Fundus photo · 2352 by 1568 pixels: 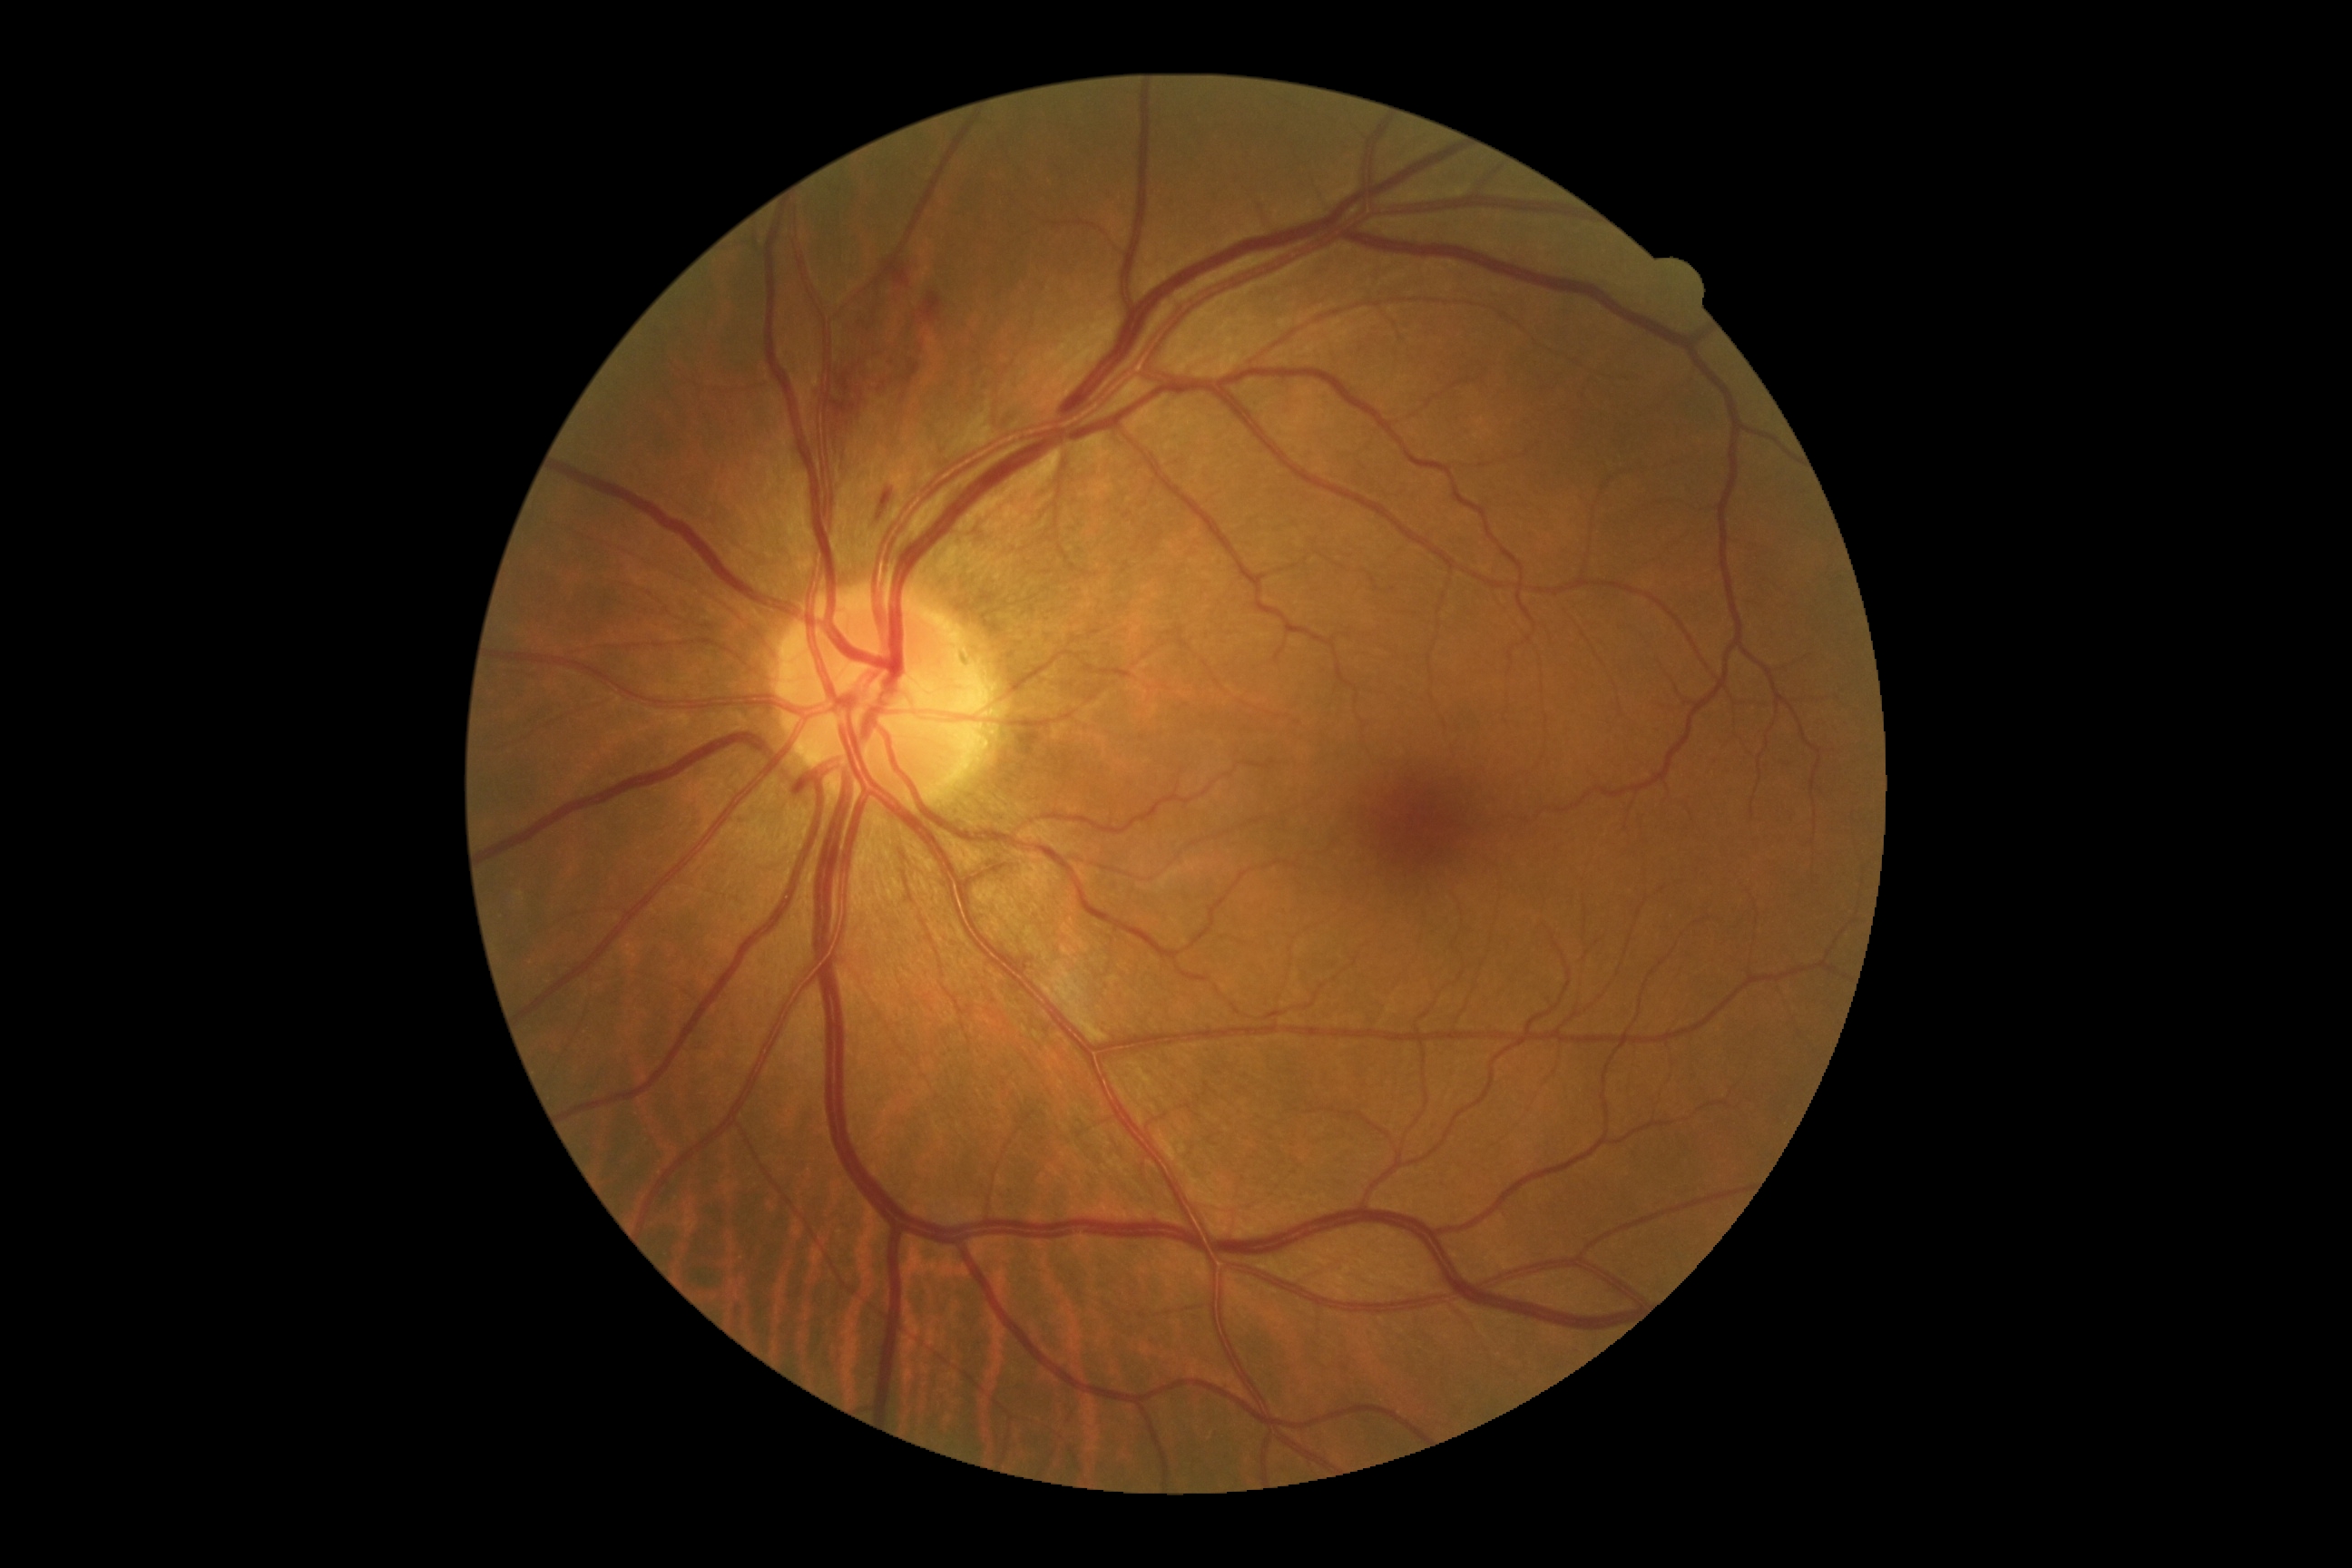

Findings:
- DR stage: moderate non-proliferative diabetic retinopathy (grade 2)